Modified Davis grading · 848x848 · fundus photo · nonmydriatic fundus photograph · NIDEK AFC-230 fundus camera: 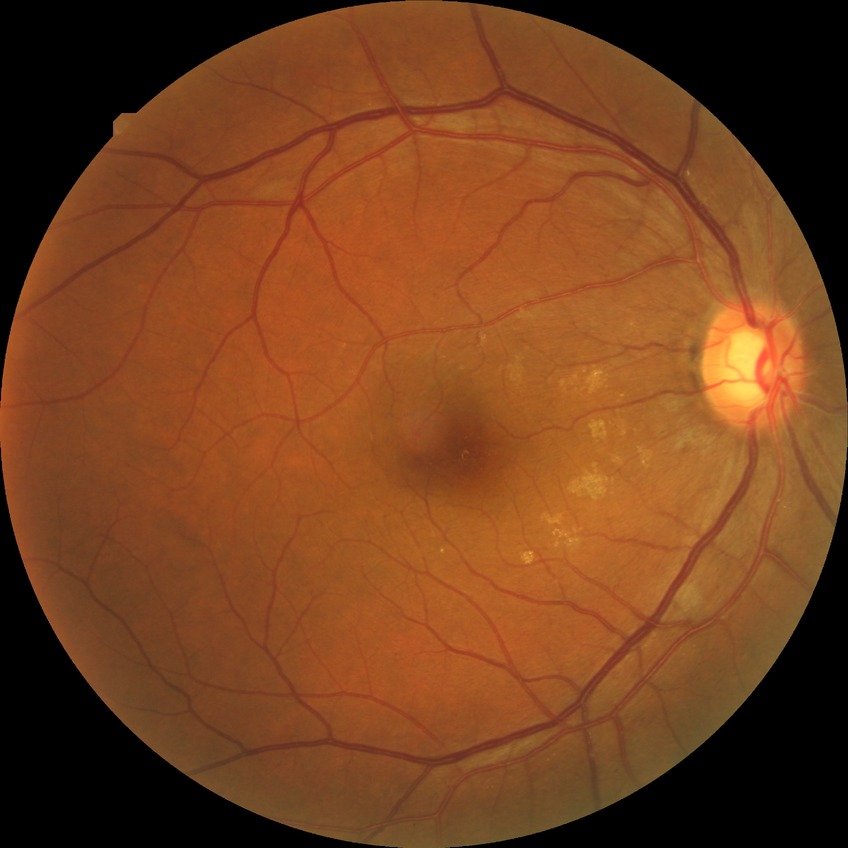
retinopathy stage: simple diabetic retinopathy.